NIDEK AFC-230 fundus camera · retinal fundus photograph · modified Davis grading — 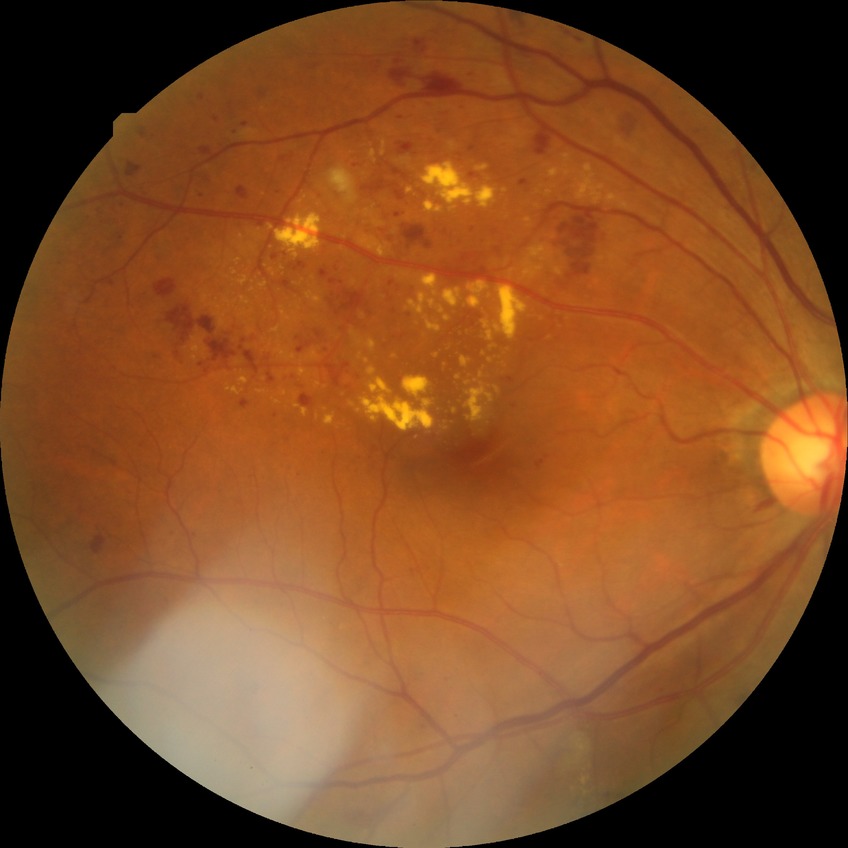 Diabetic retinopathy (DR) is PPDR (pre-proliferative diabetic retinopathy).